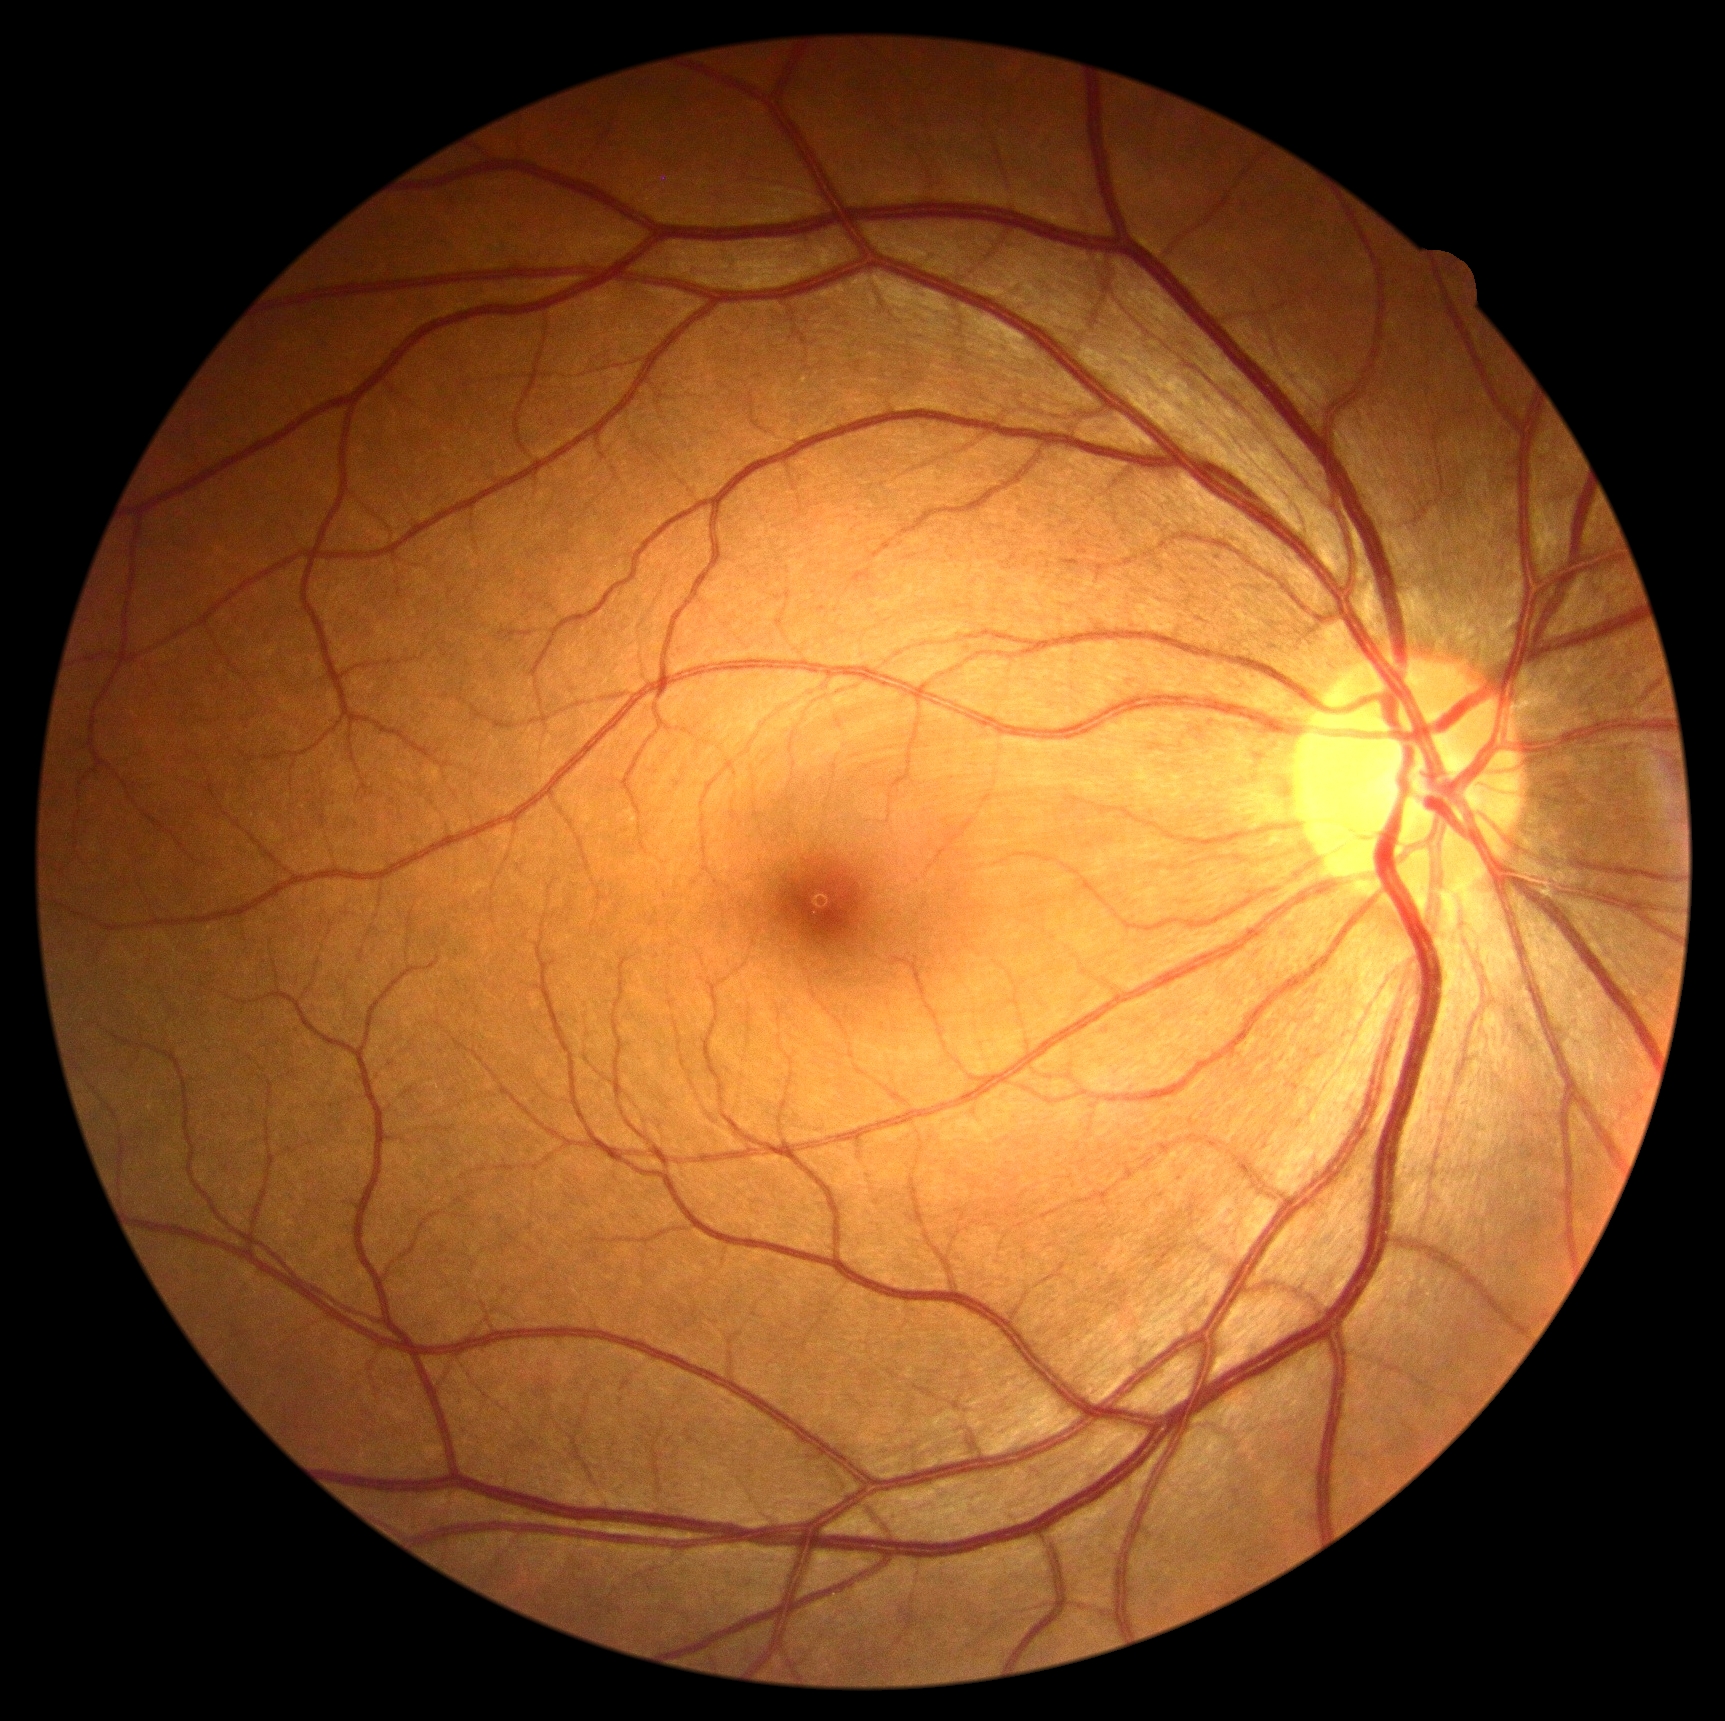 No diabetic retinal disease findings. Diabetic retinopathy is grade 0 (no apparent retinopathy).